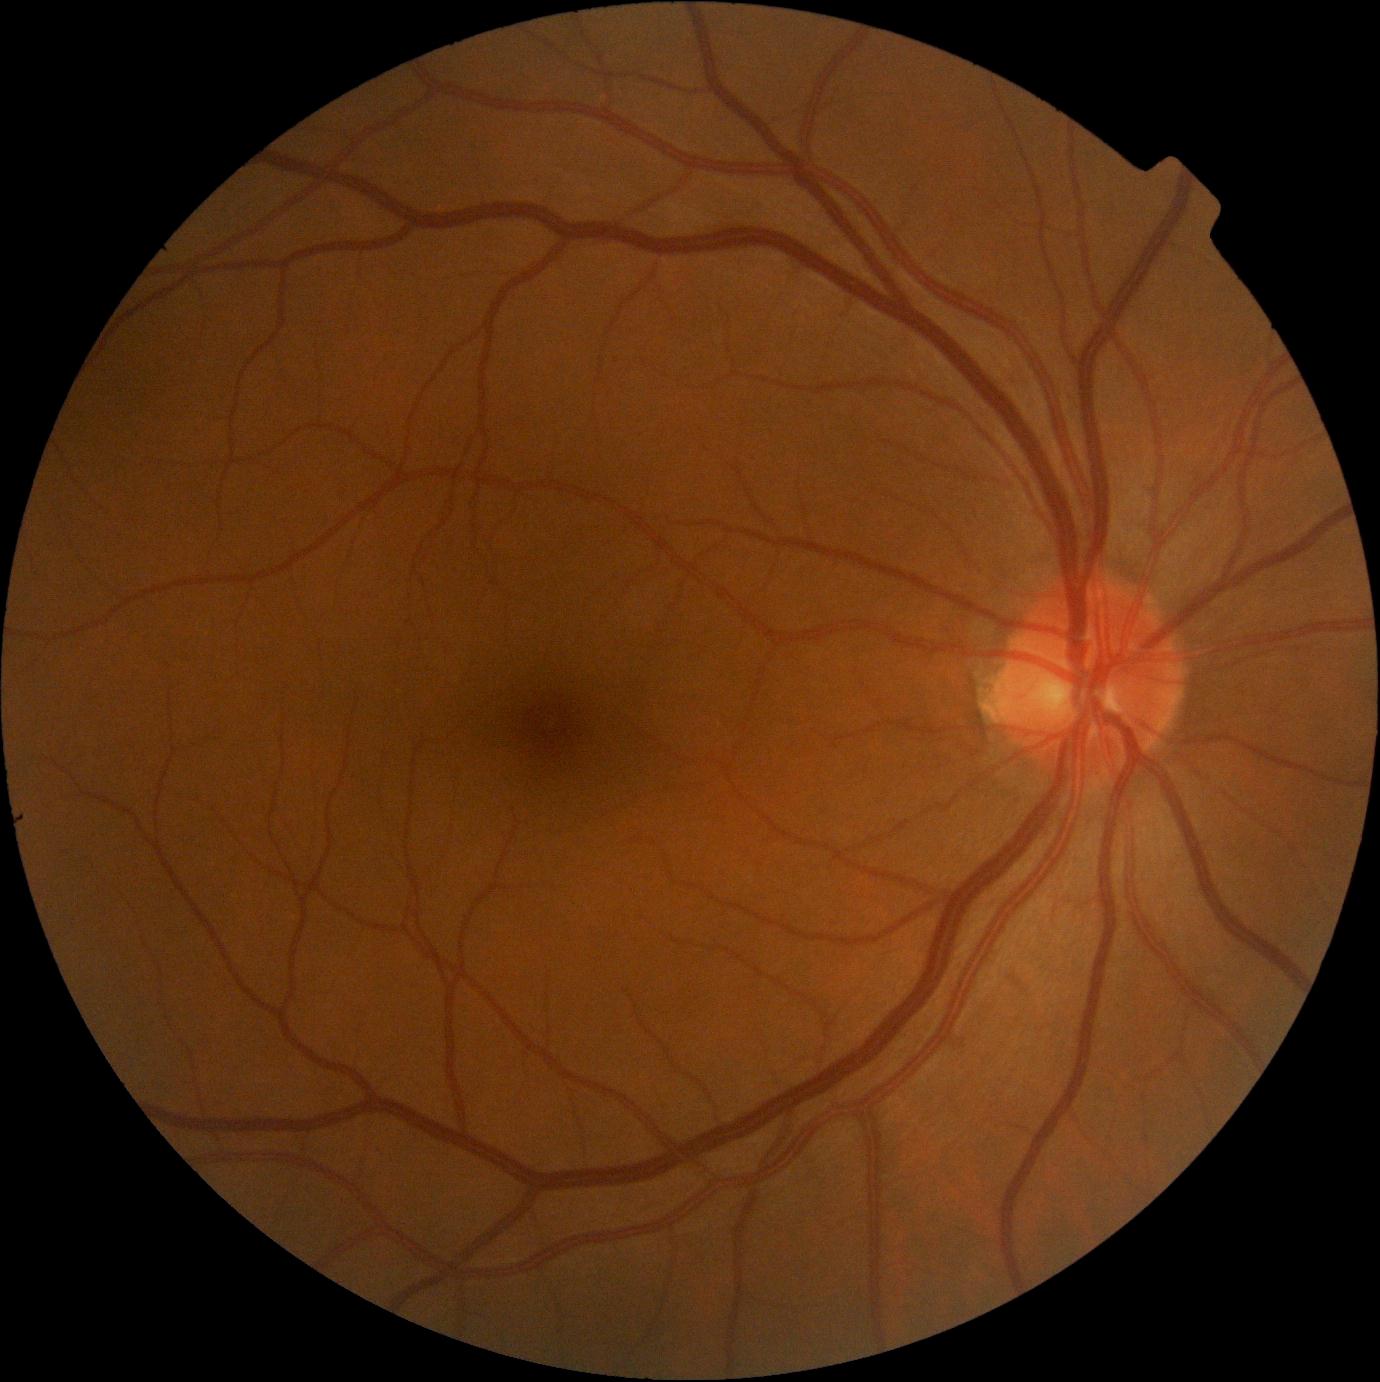 No diabetic retinal disease findings. Diabetic retinopathy (DR): grade 0.